Wide-field fundus photograph of an infant; 640x480px
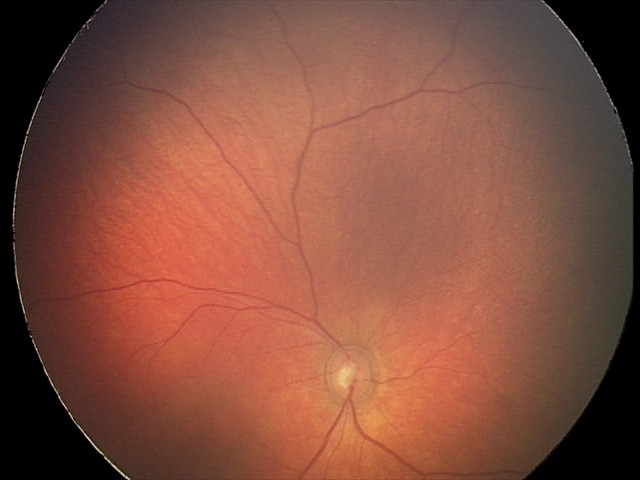

Q: What is the diagnosis from this examination?
A: retinal hemorrhages